Camera: NIDEK AFC-230 · nonmydriatic fundus photograph · DR severity per modified Davis staging: 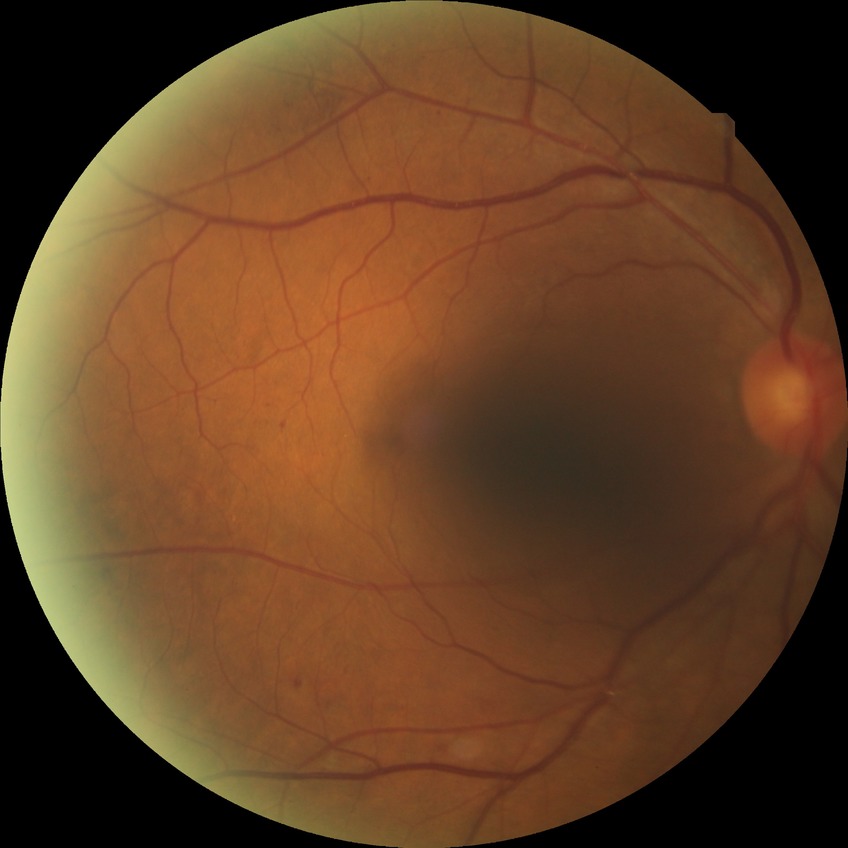 {"davis_grade": "simple diabetic retinopathy"}